Pediatric retinal photograph (wide-field); 640 x 480 pixels: 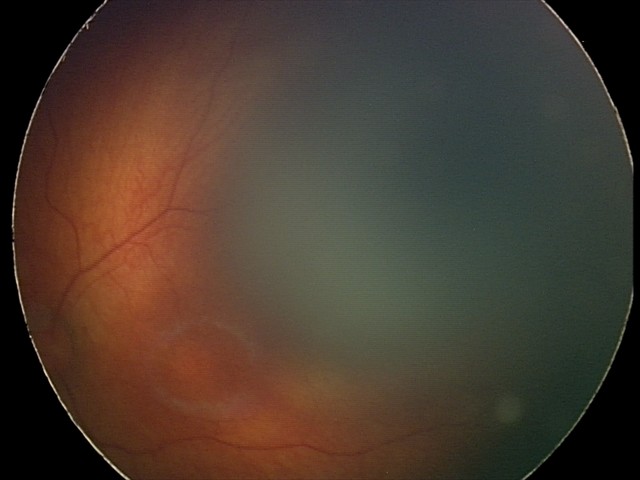 Screening: normal fundus examination.